Retinal fundus photograph: 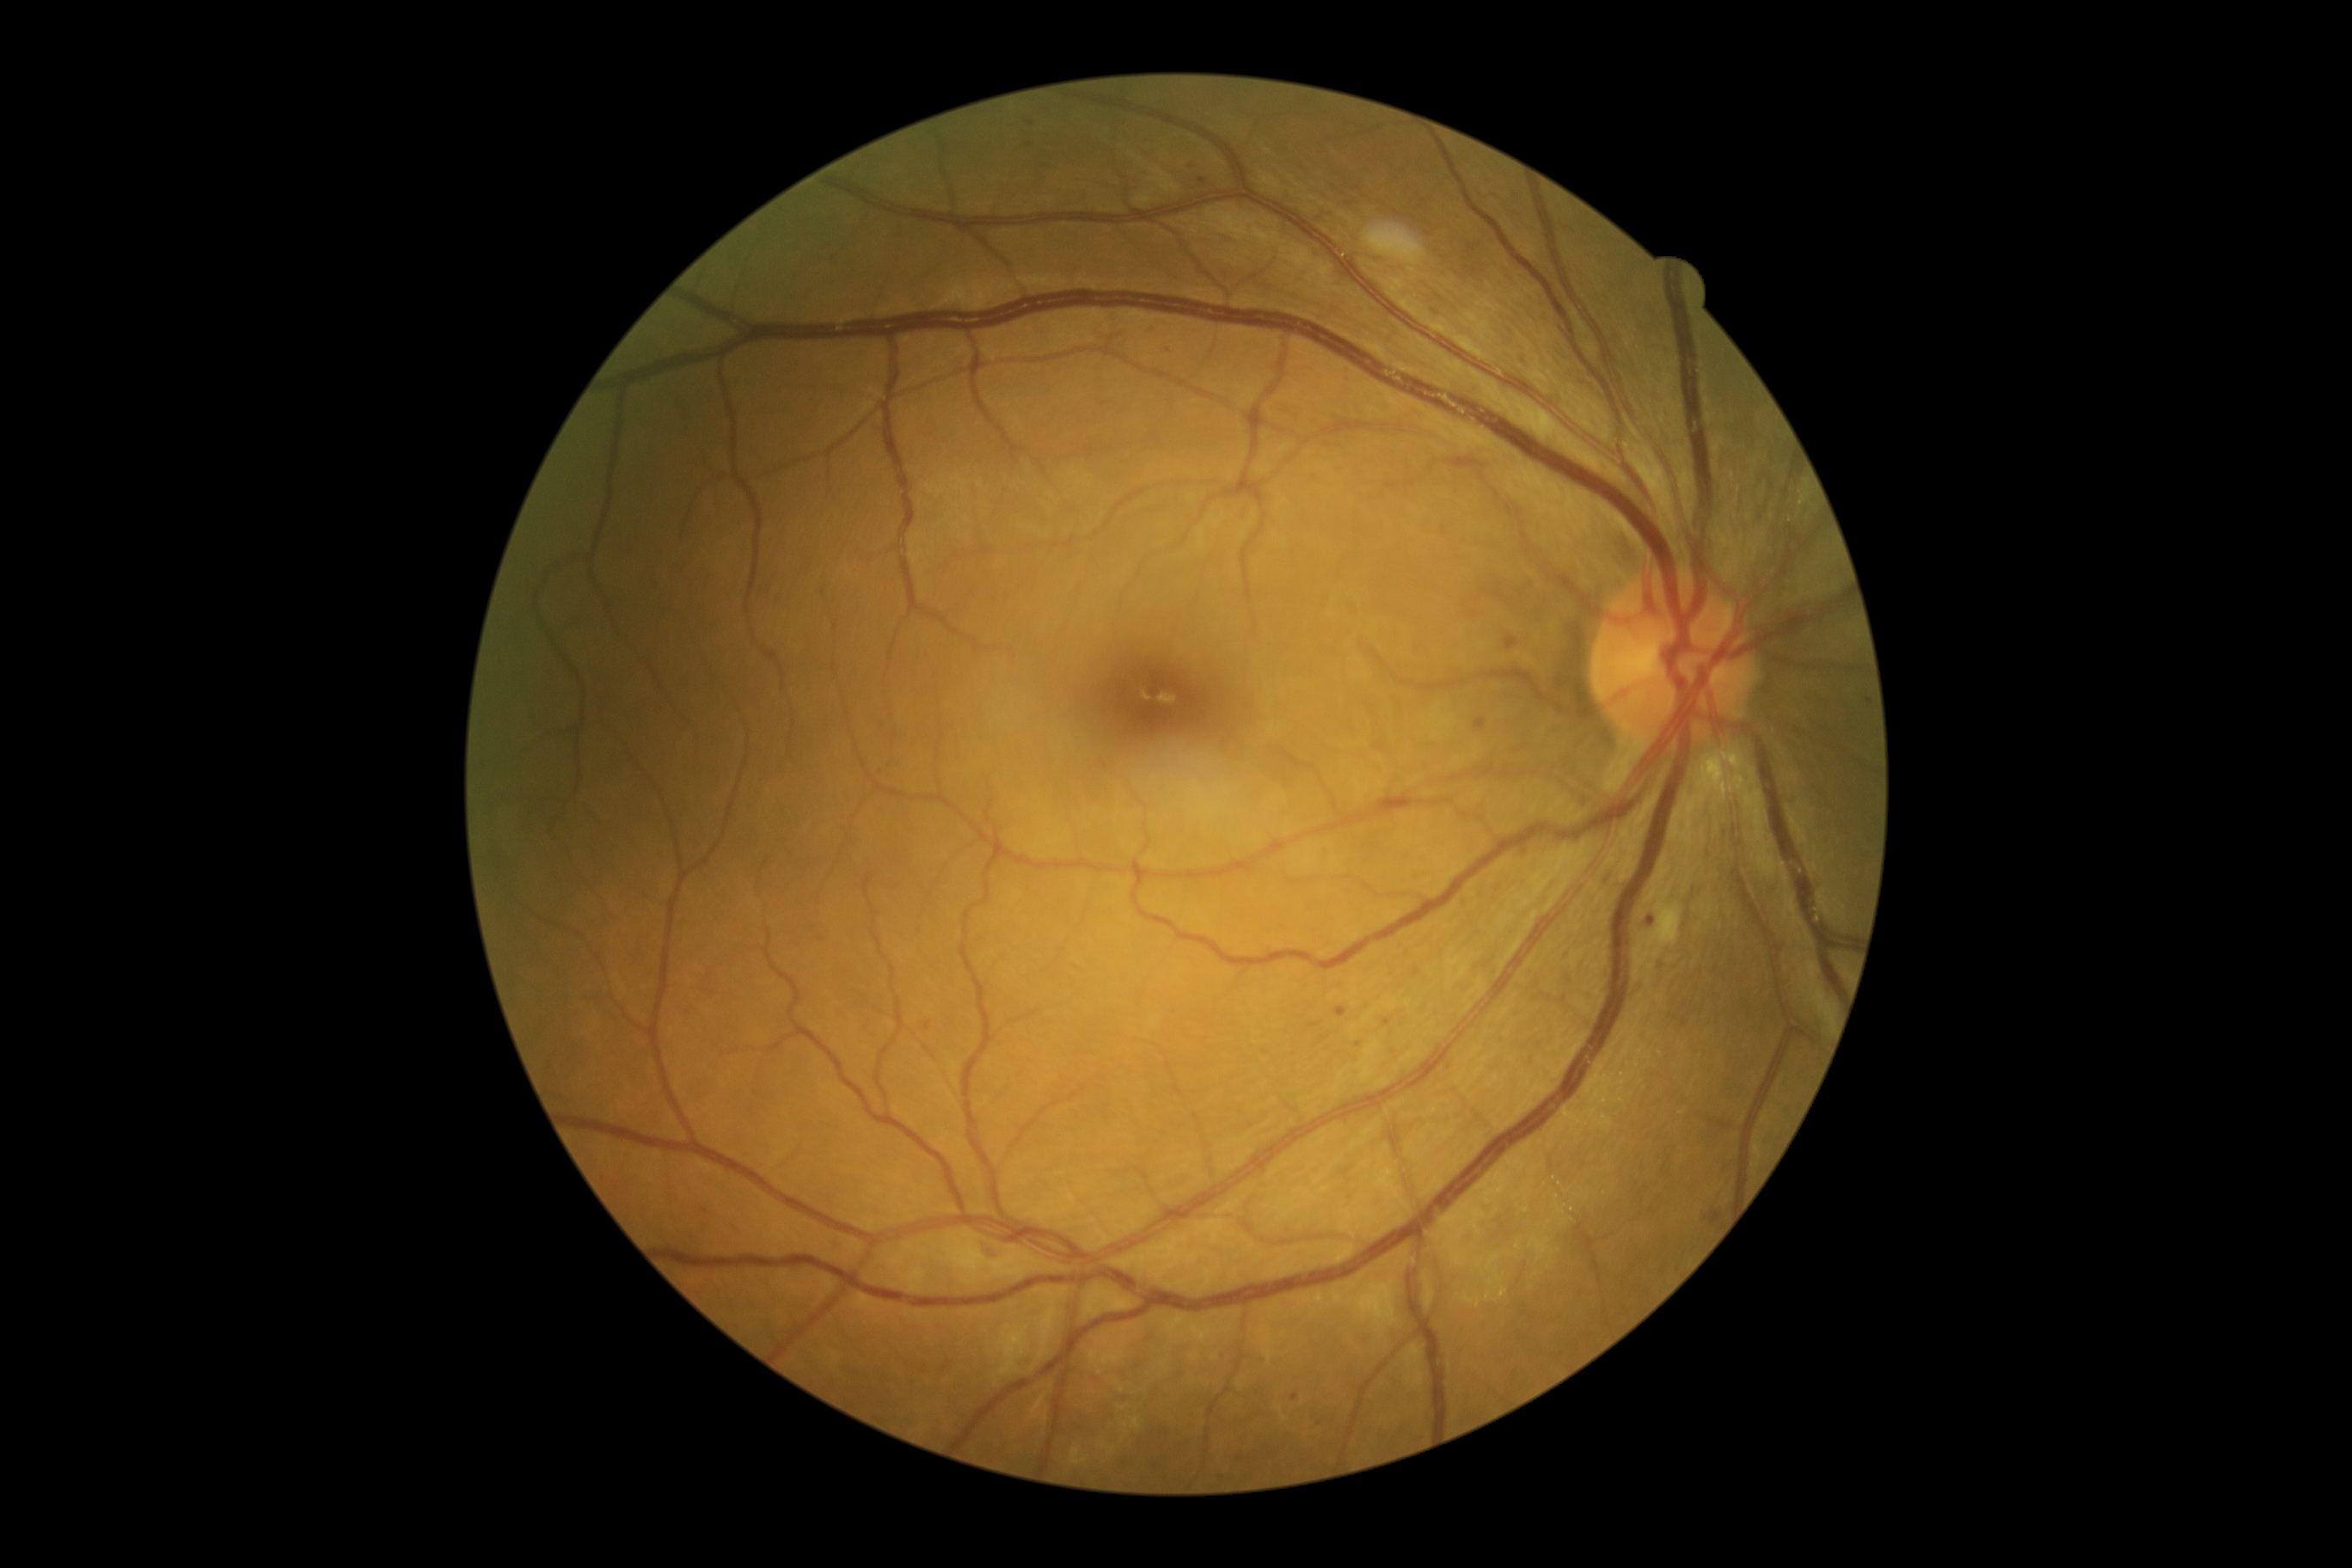

DR severity is moderate non-proliferative diabetic retinopathy (grade 2)
Selected lesions:
* MAs (subset): bbox=[1576, 381, 1584, 388], bbox=[1115, 329, 1127, 340], bbox=[1560, 838, 1565, 847], bbox=[835, 1246, 845, 1254], bbox=[1383, 1019, 1392, 1027], bbox=[1646, 922, 1660, 934], bbox=[1187, 168, 1197, 173], bbox=[979, 1239, 1001, 1254], bbox=[1163, 346, 1172, 355], bbox=[1555, 575, 1569, 585]
* Additional small MAs near {"x": 1202, "y": 182}, {"x": 1684, "y": 1023}, {"x": 1440, "y": 312}
* EXs: bbox=[1705, 764, 1718, 785], bbox=[1729, 756, 1739, 764], bbox=[1736, 773, 1744, 787]
* SEs: bbox=[1663, 916, 1684, 948]
* HEs: none